Pediatric wide-field fundus photograph.
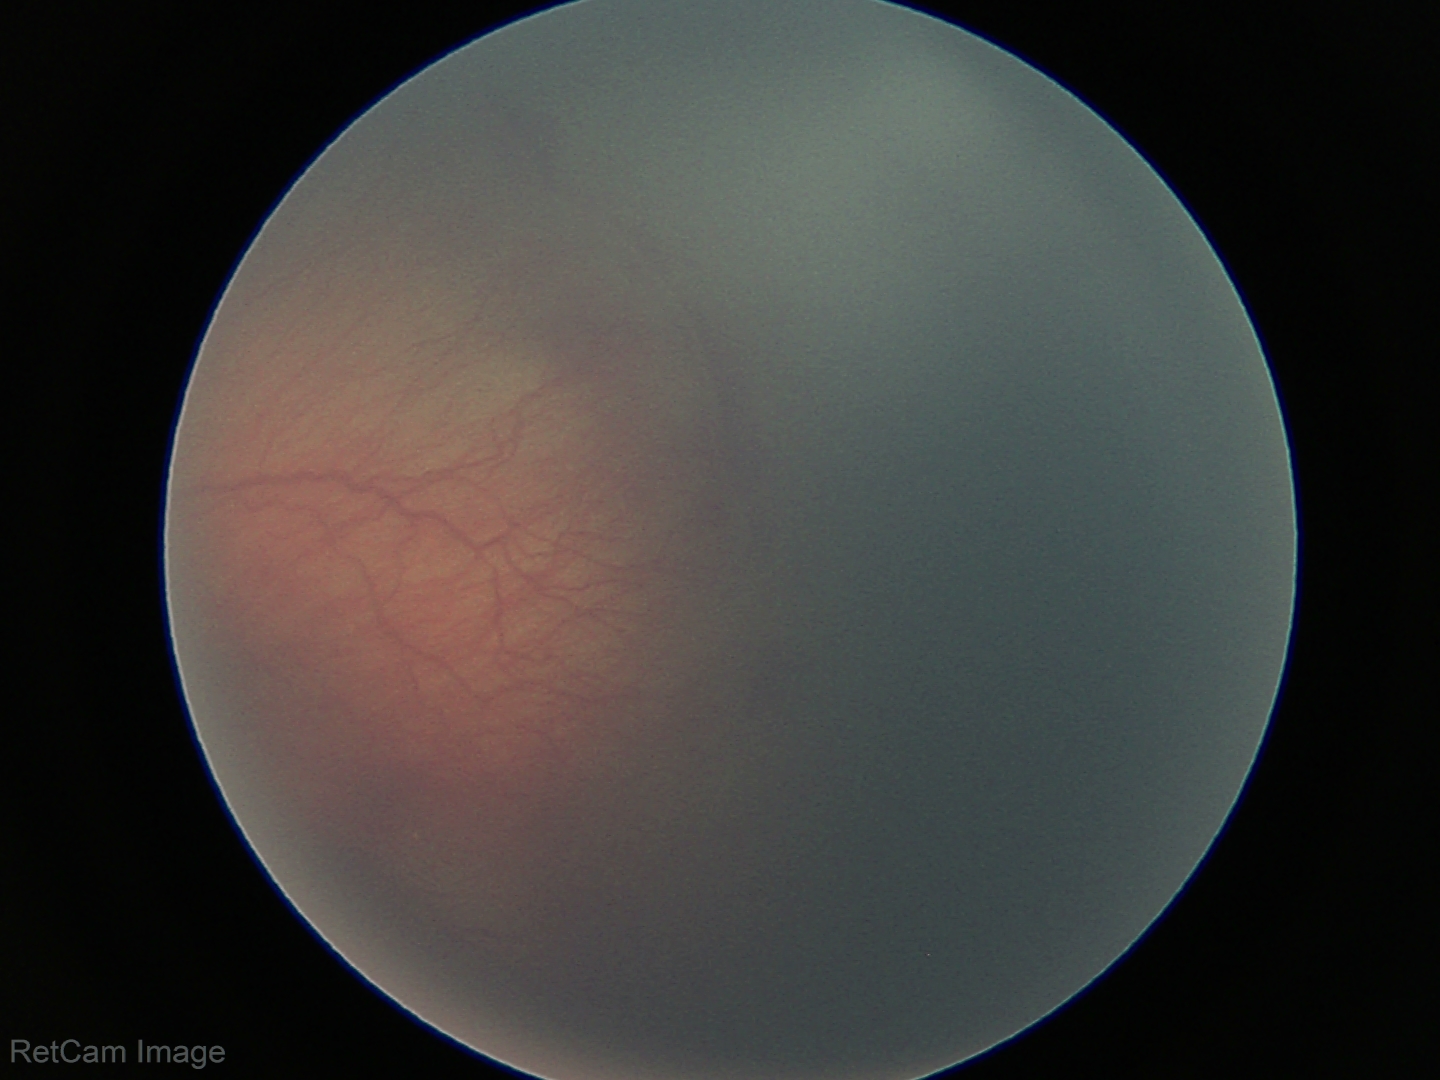

Screening examination consistent with retinopathy of prematurity stage 2.